Wide-field fundus image from infant ROP screening · 130° field of view (Clarity RetCam 3) · image size 640x480 — 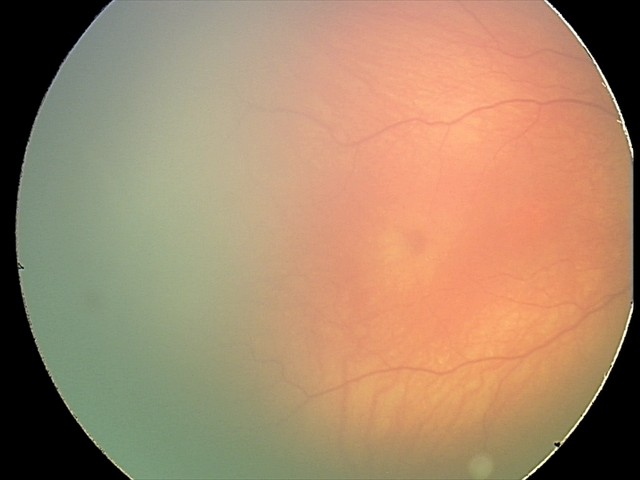

From an examination with diagnosis of status post ROP — retinal appearance after treated retinopathy of prematurity.